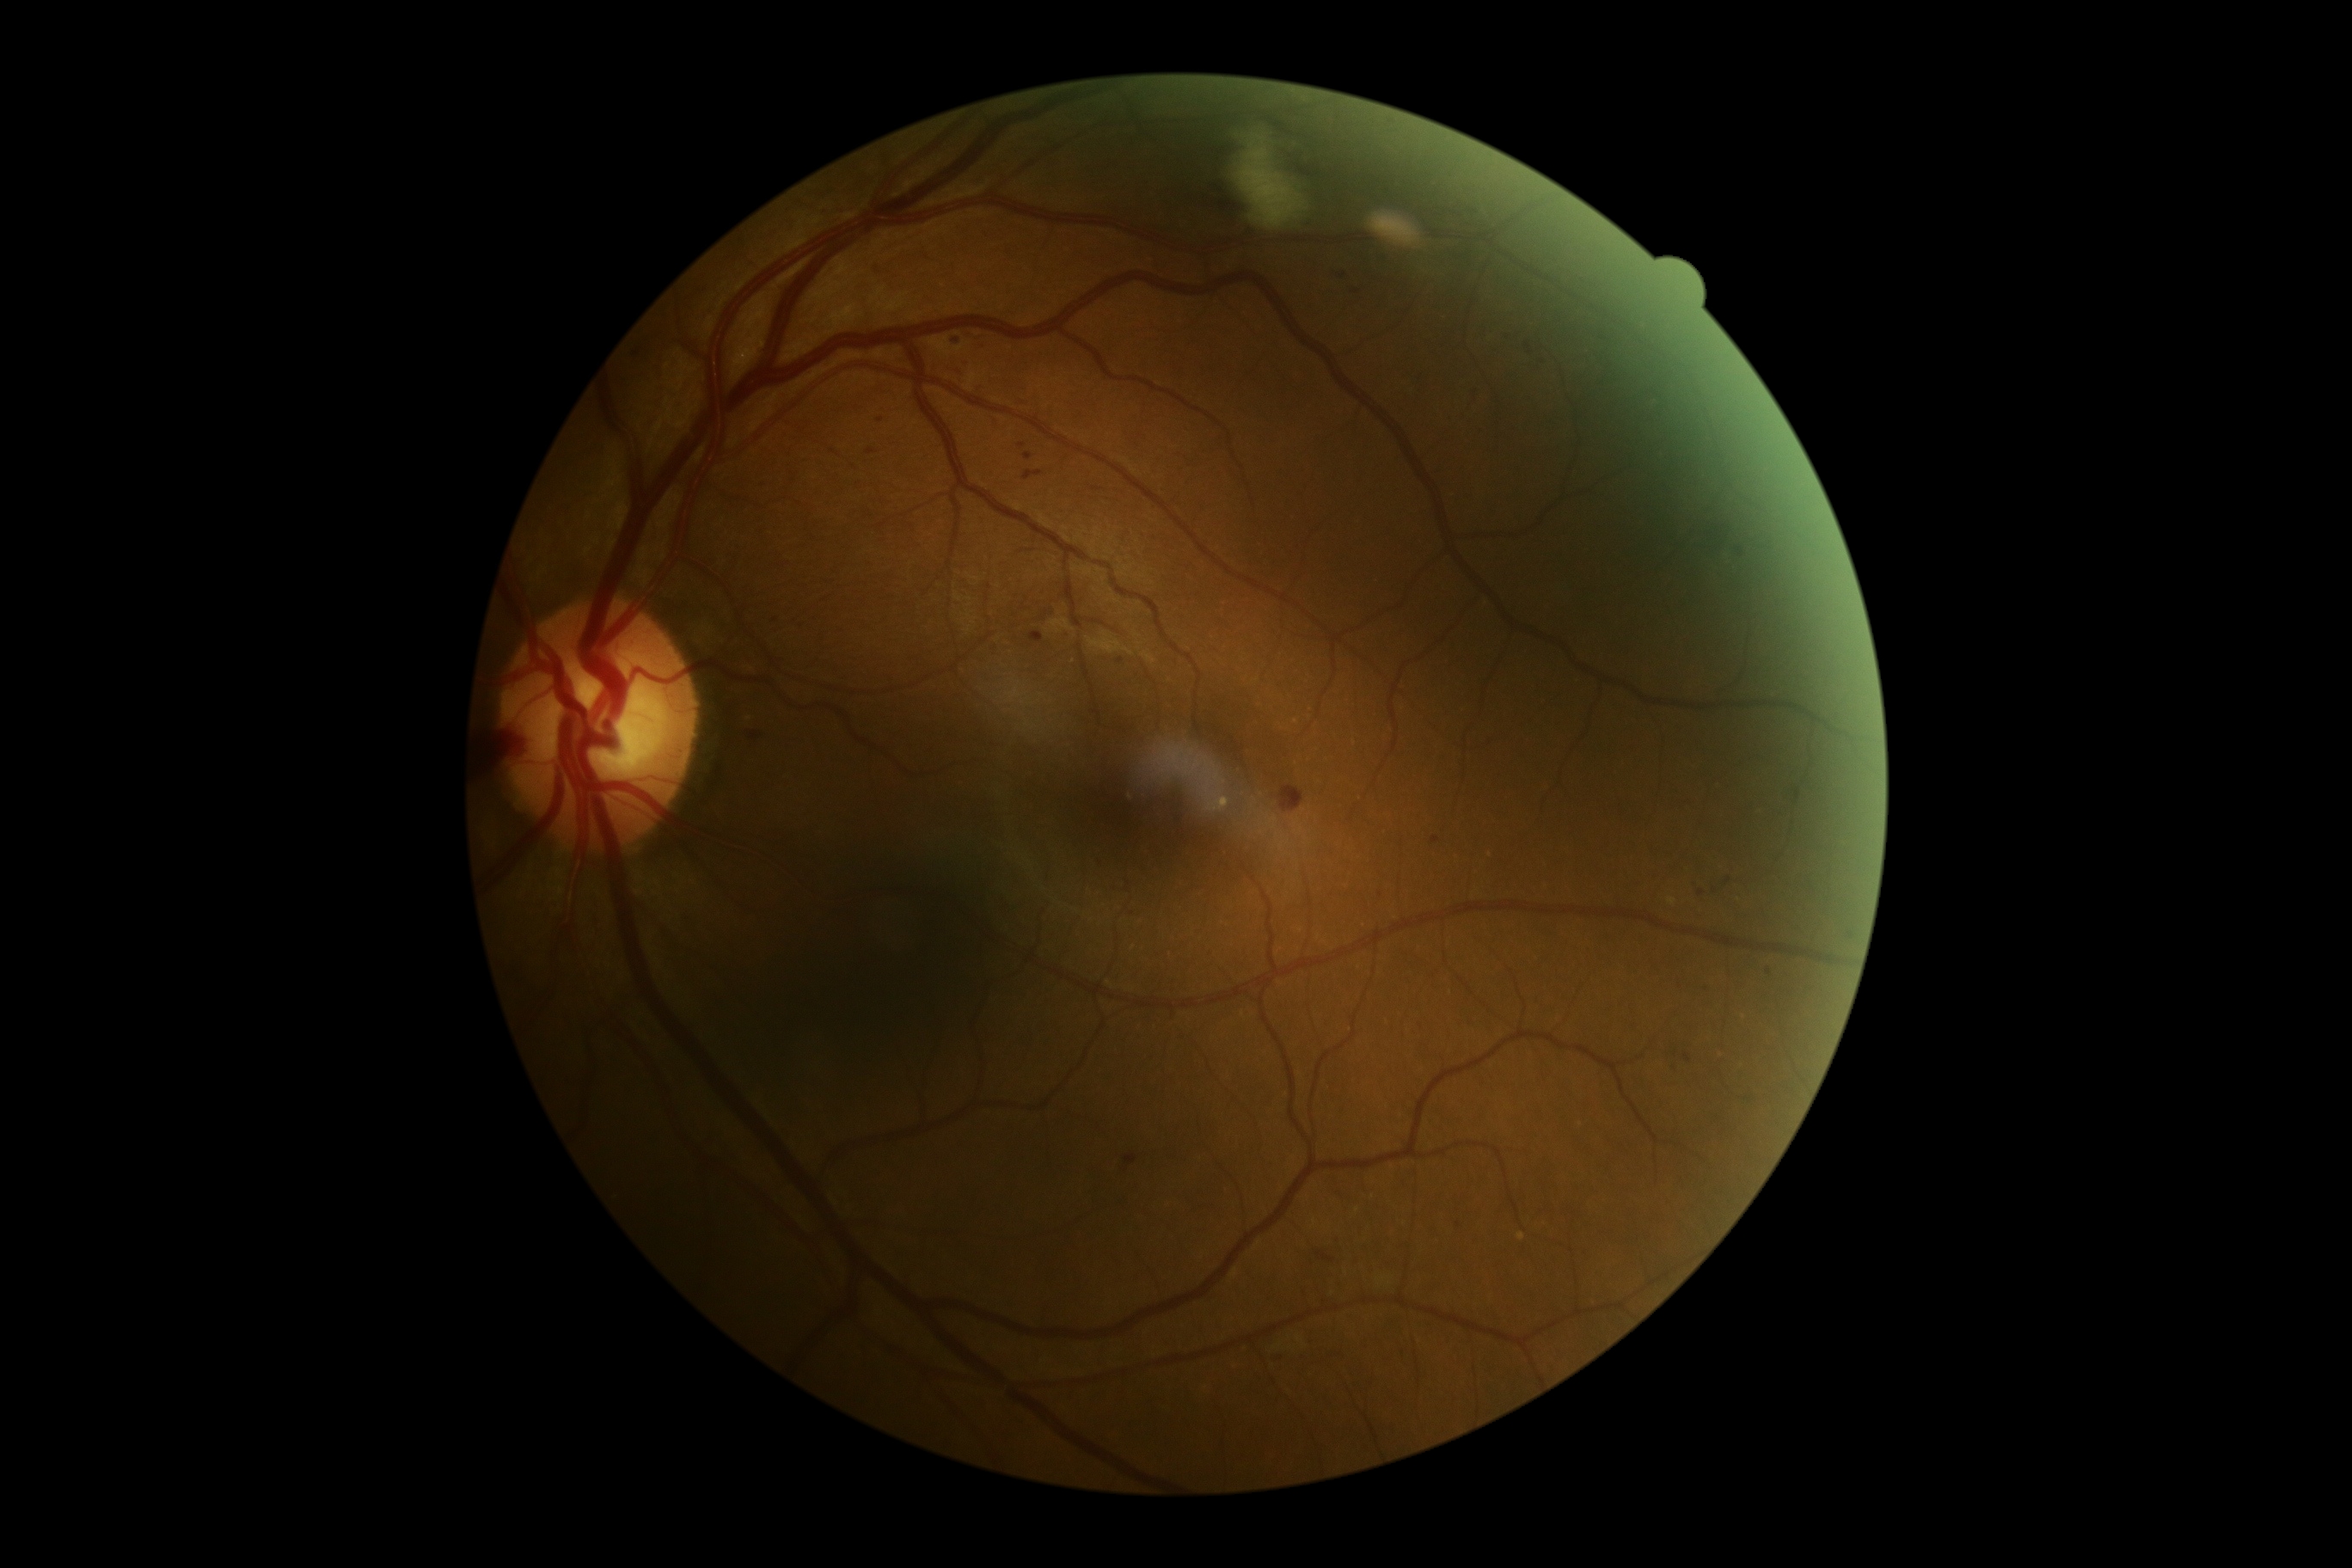
DR severity: moderate NPDR (grade 2) — more than just microaneurysms but less than severe NPDR.